Fundus photo.
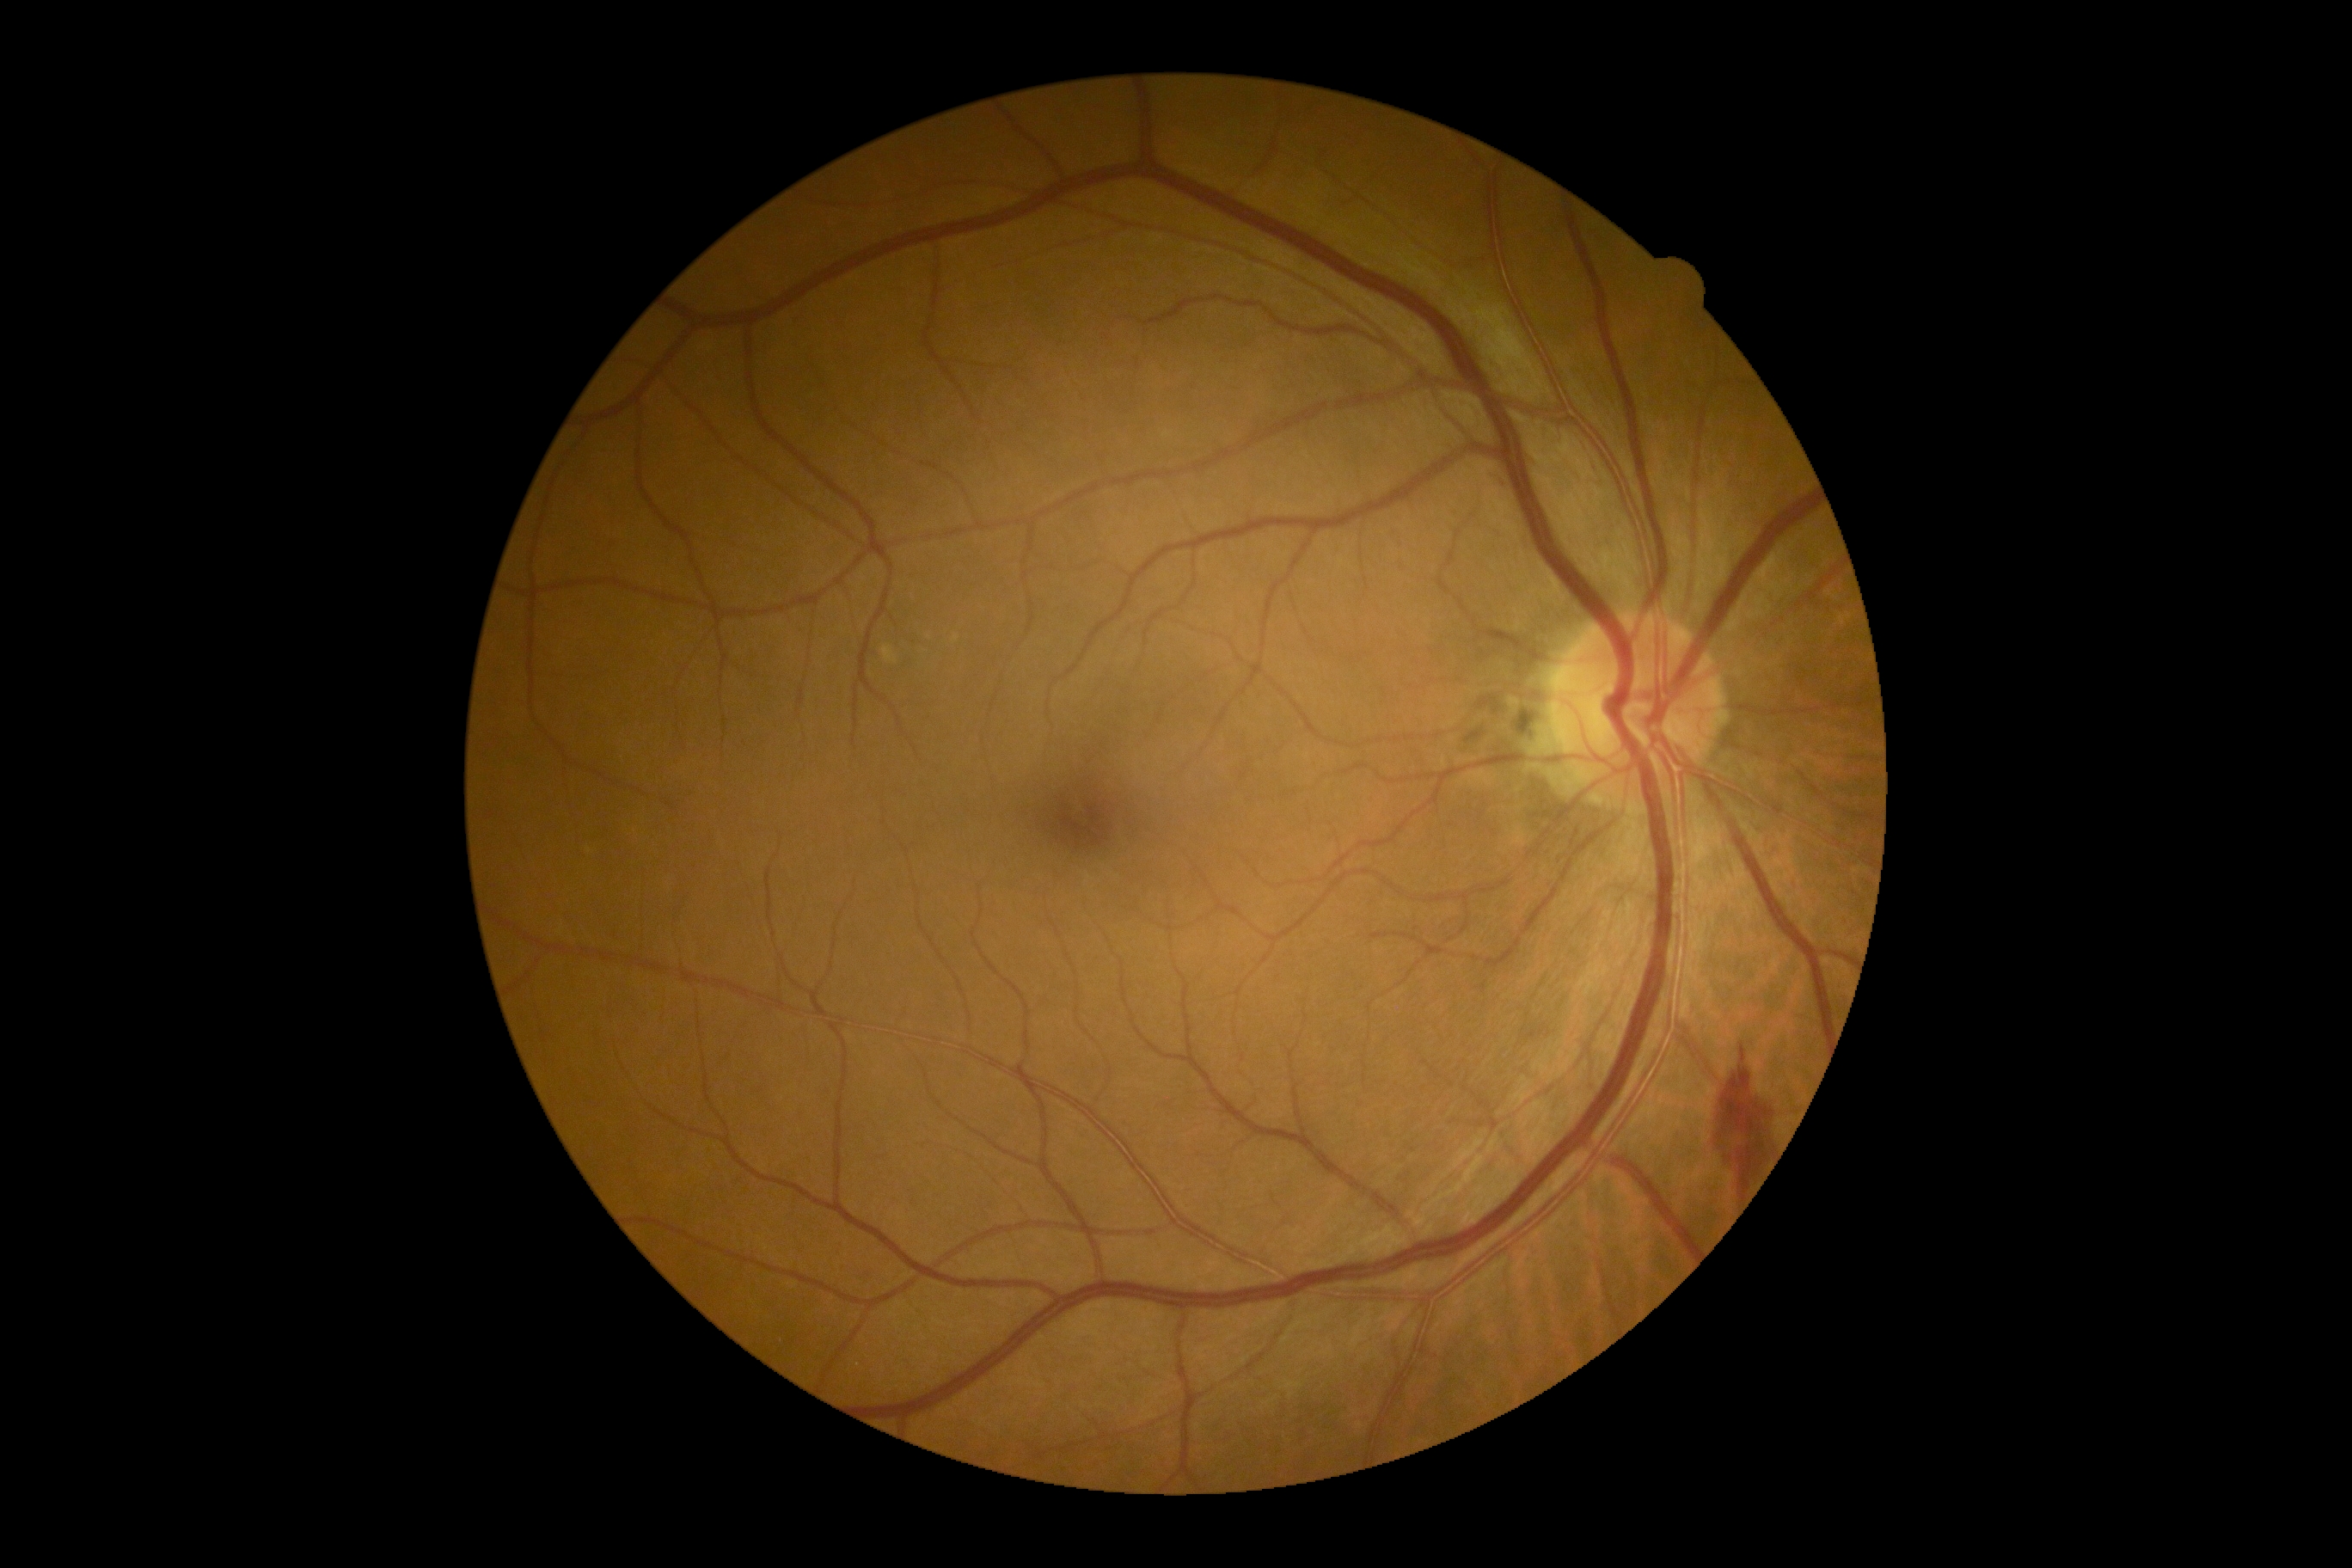
retinopathy=moderate NPDR (grade 2), DR class=non-proliferative diabetic retinopathy.